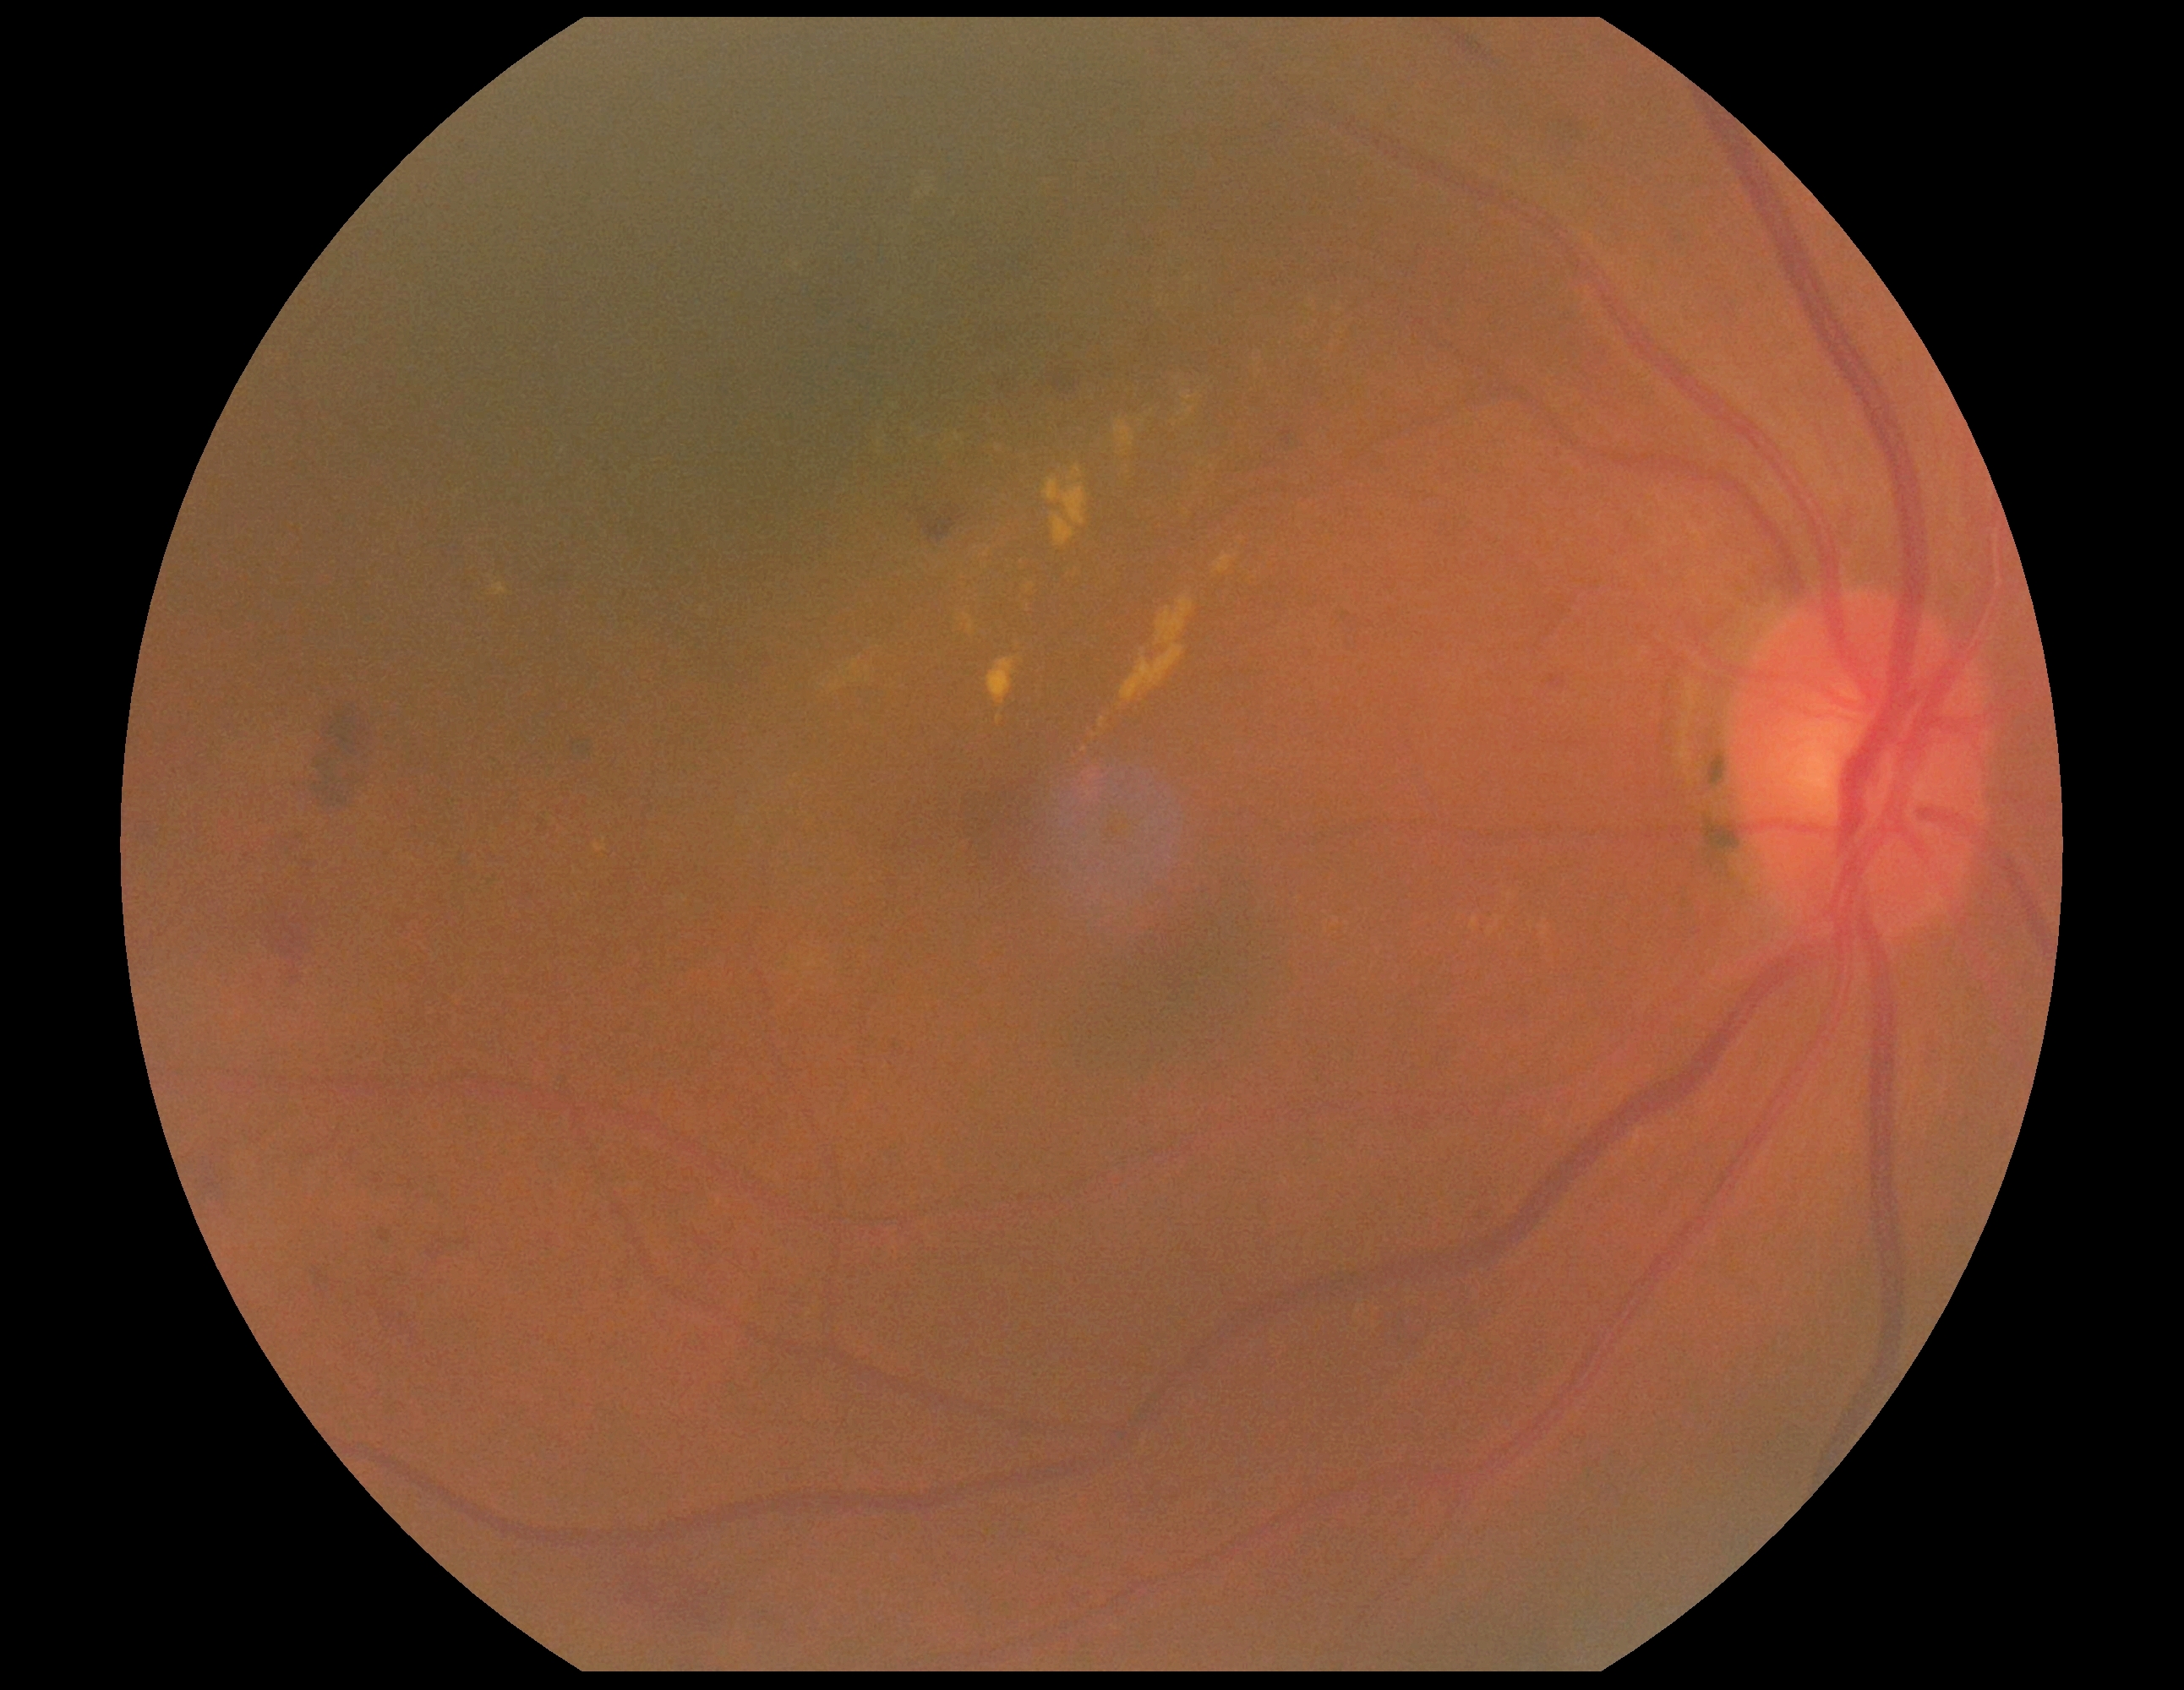
DR stage: grade 2 (moderate NPDR).